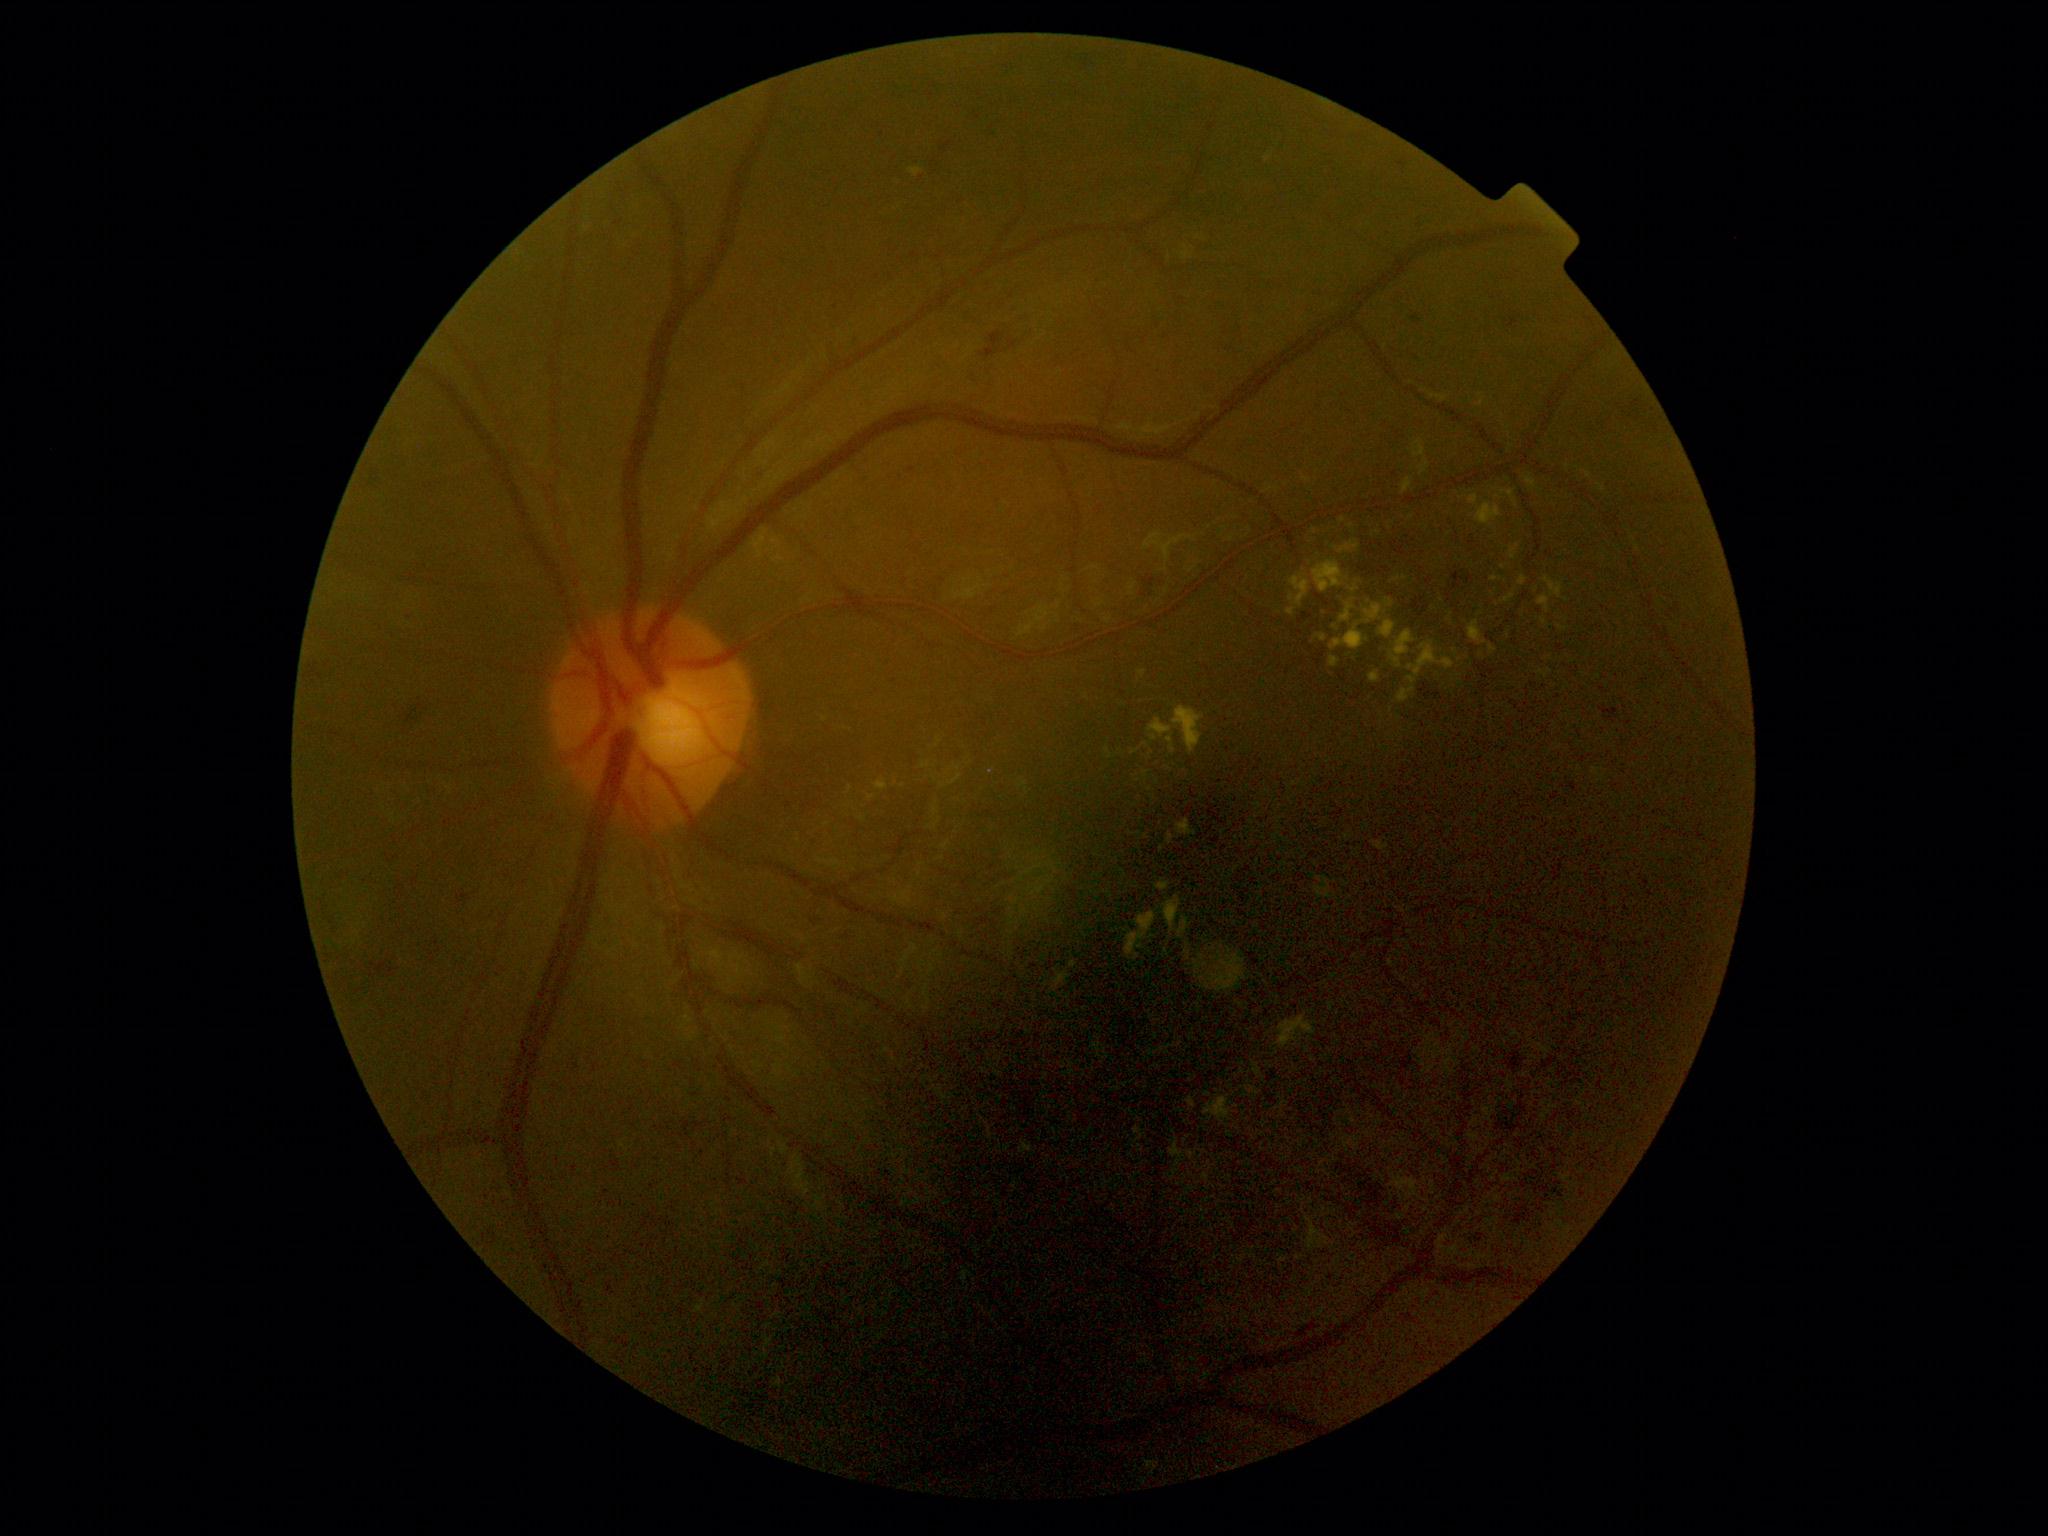

Retinopathy grade is 2
Representative lesions:
hard exudates (subset) = 908,168,924,178; 1305,1217,1335,1253; 1289,575,1310,608; 1491,577,1503,582; 1545,577,1563,599; 1167,833,1175,845; 1489,645,1497,655; 1468,494,1478,506; 1155,879,1171,892; 1134,1128,1145,1154
Small hard exudates near <point>1562, 628</point>; <point>1139, 834</point>; <point>1145, 745</point>; <point>1536, 590</point>; <point>1504, 568</point>; <point>1150, 790</point>; <point>1481, 655</point>